45° field of view; 1536x1152px; retinal fundus photograph: 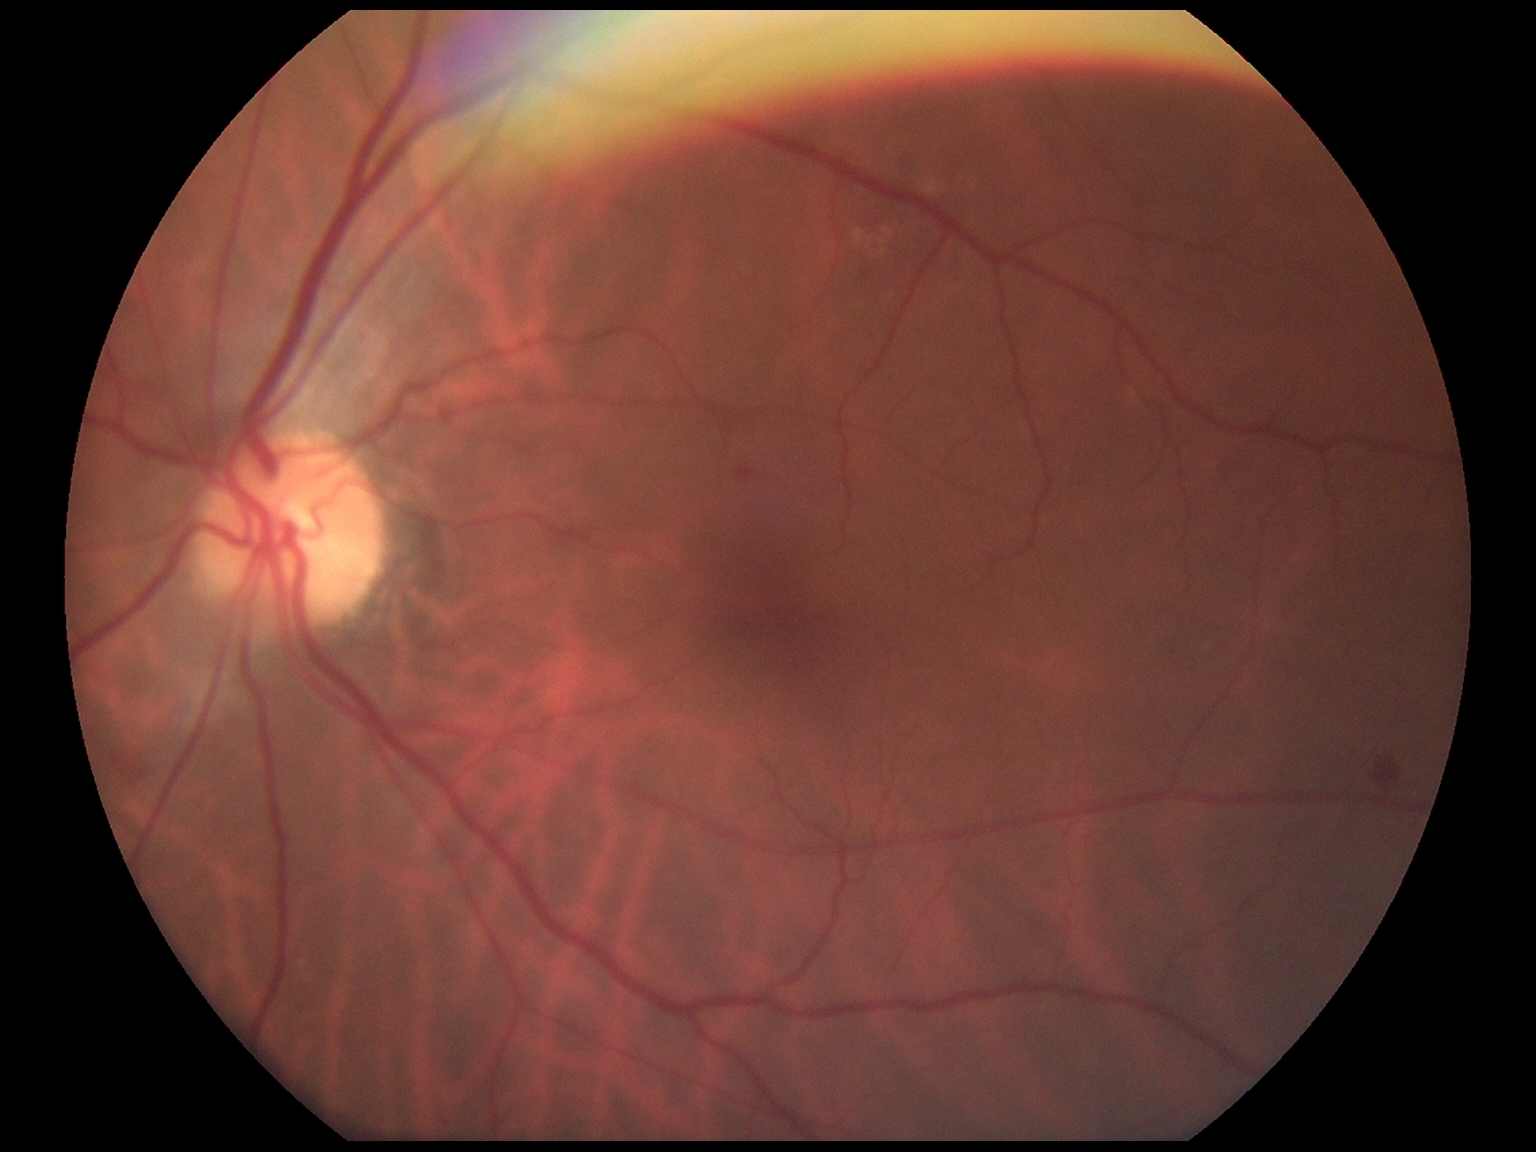

diabetic retinopathy grade=moderate non-proliferative diabetic retinopathy (2).